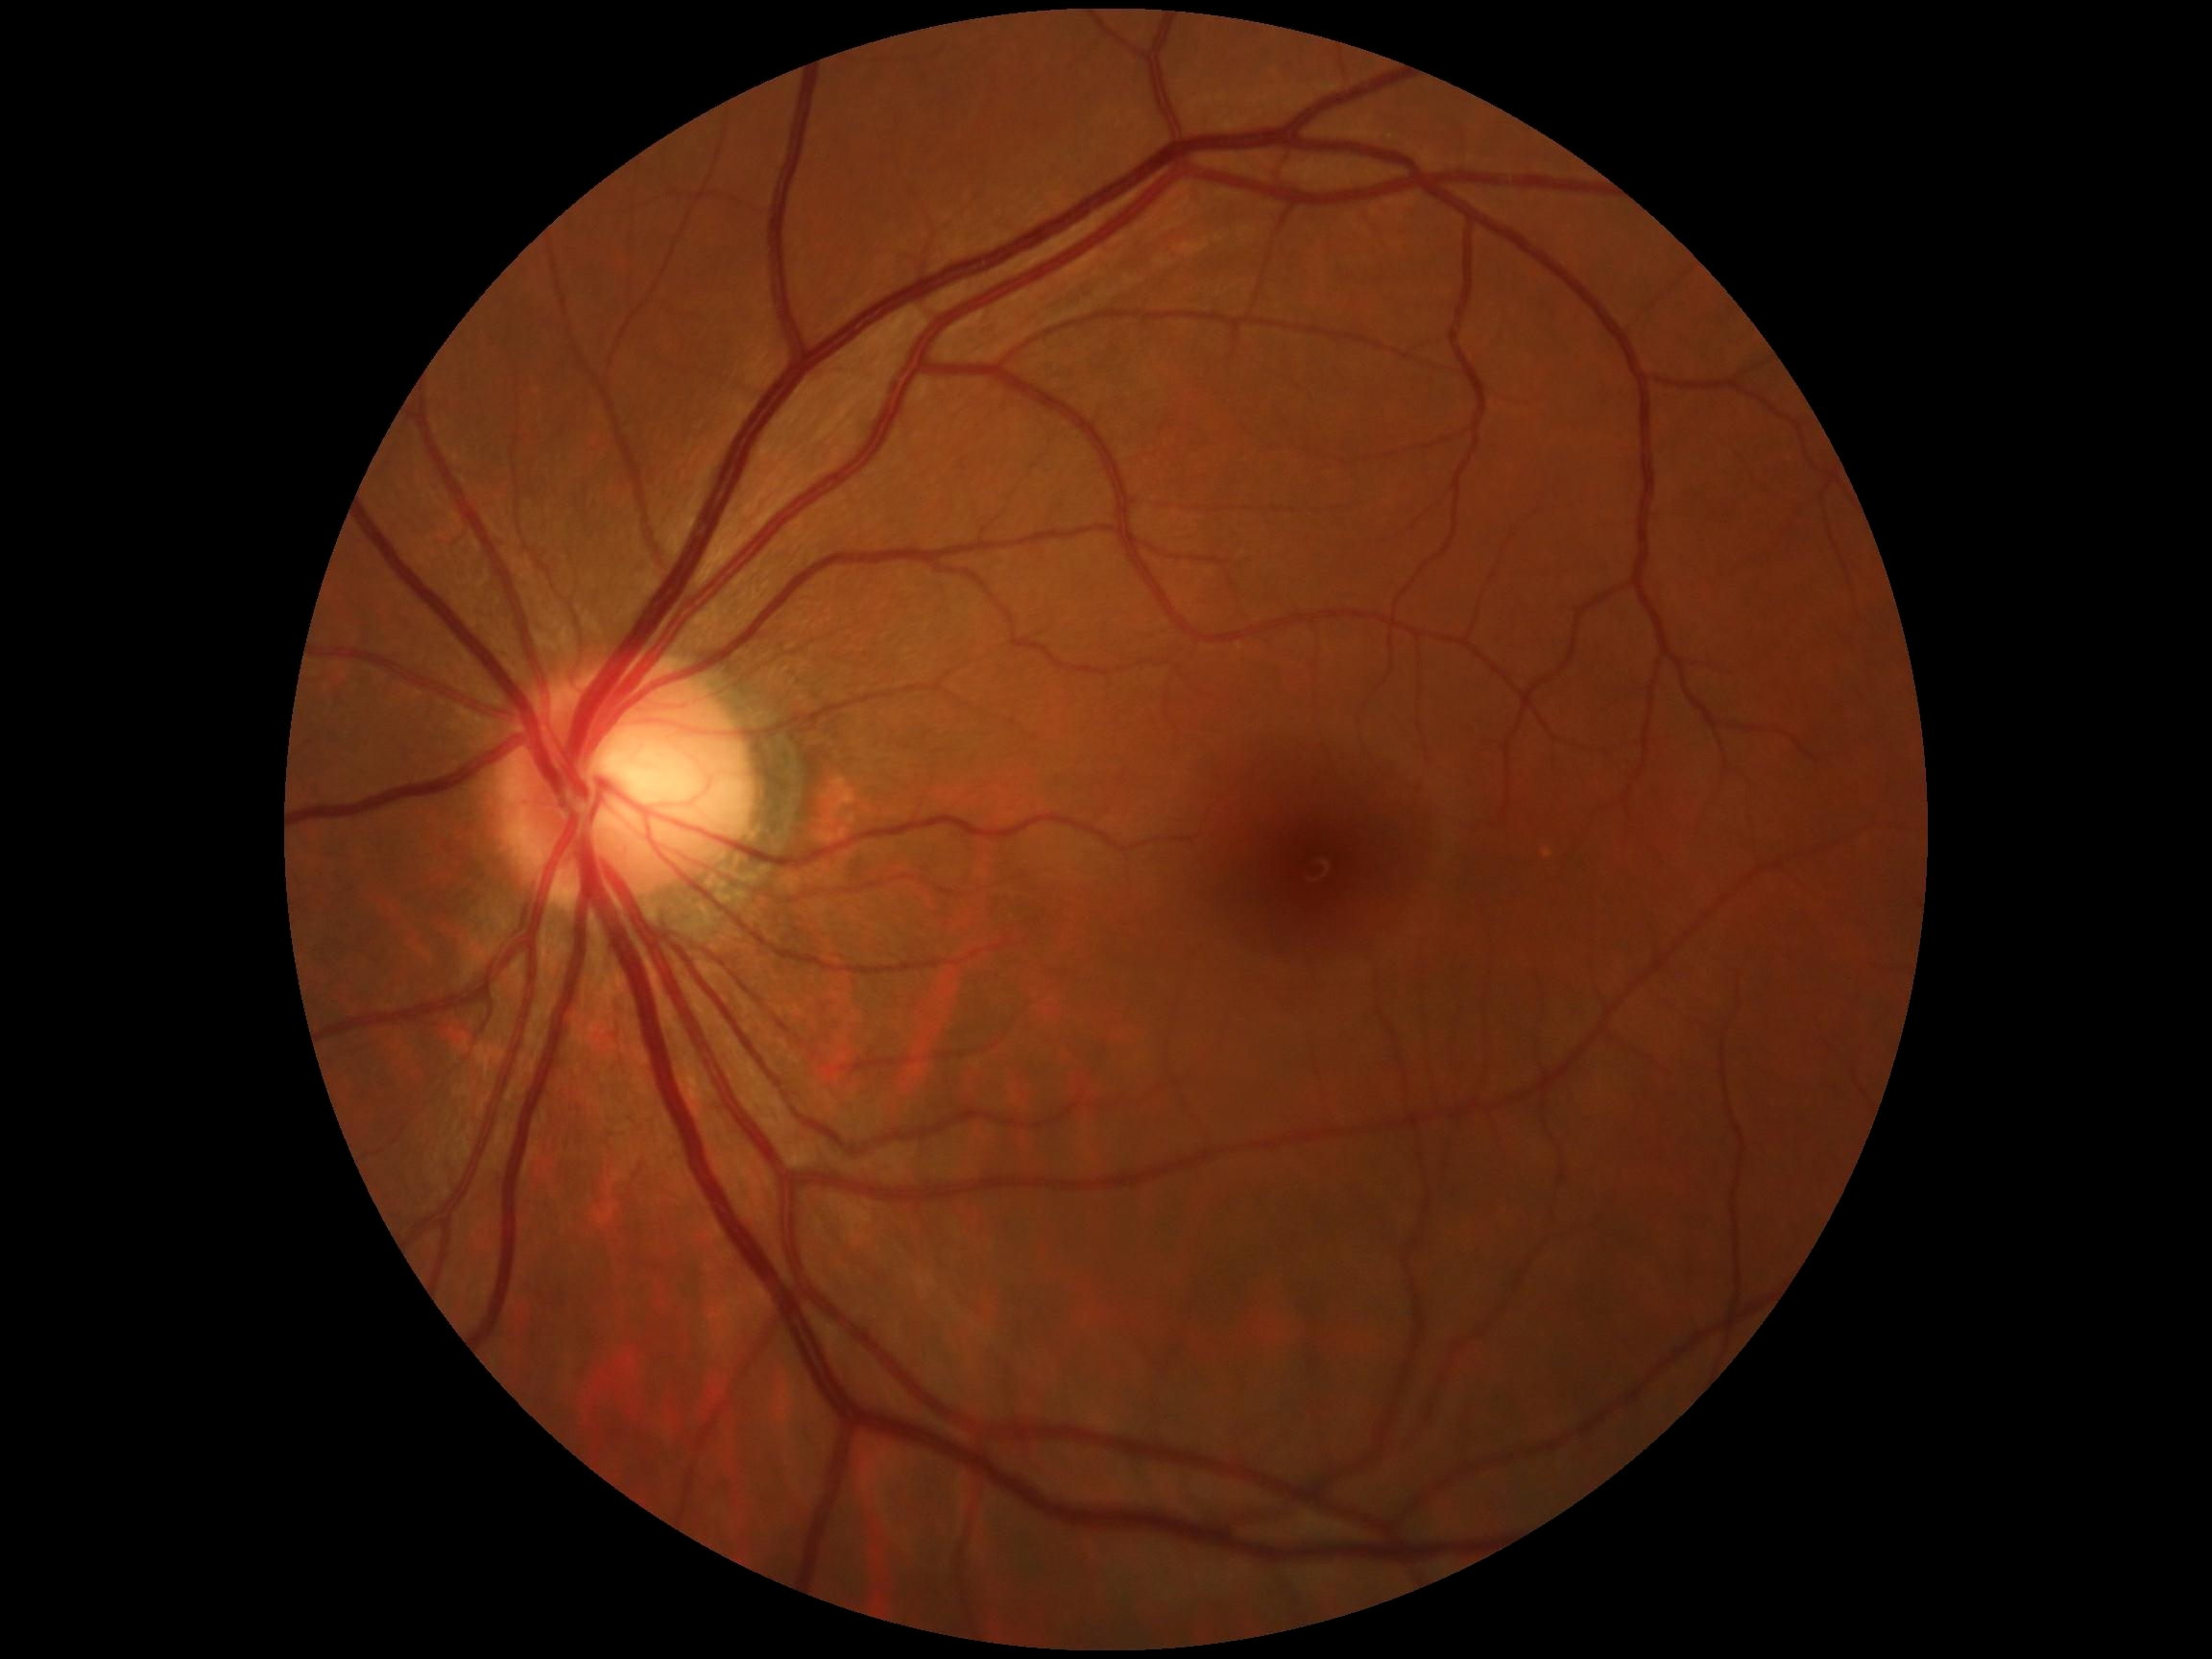 No apparent diabetic retinopathy.
Diabetic retinopathy grade: 0.